45-degree field of view:
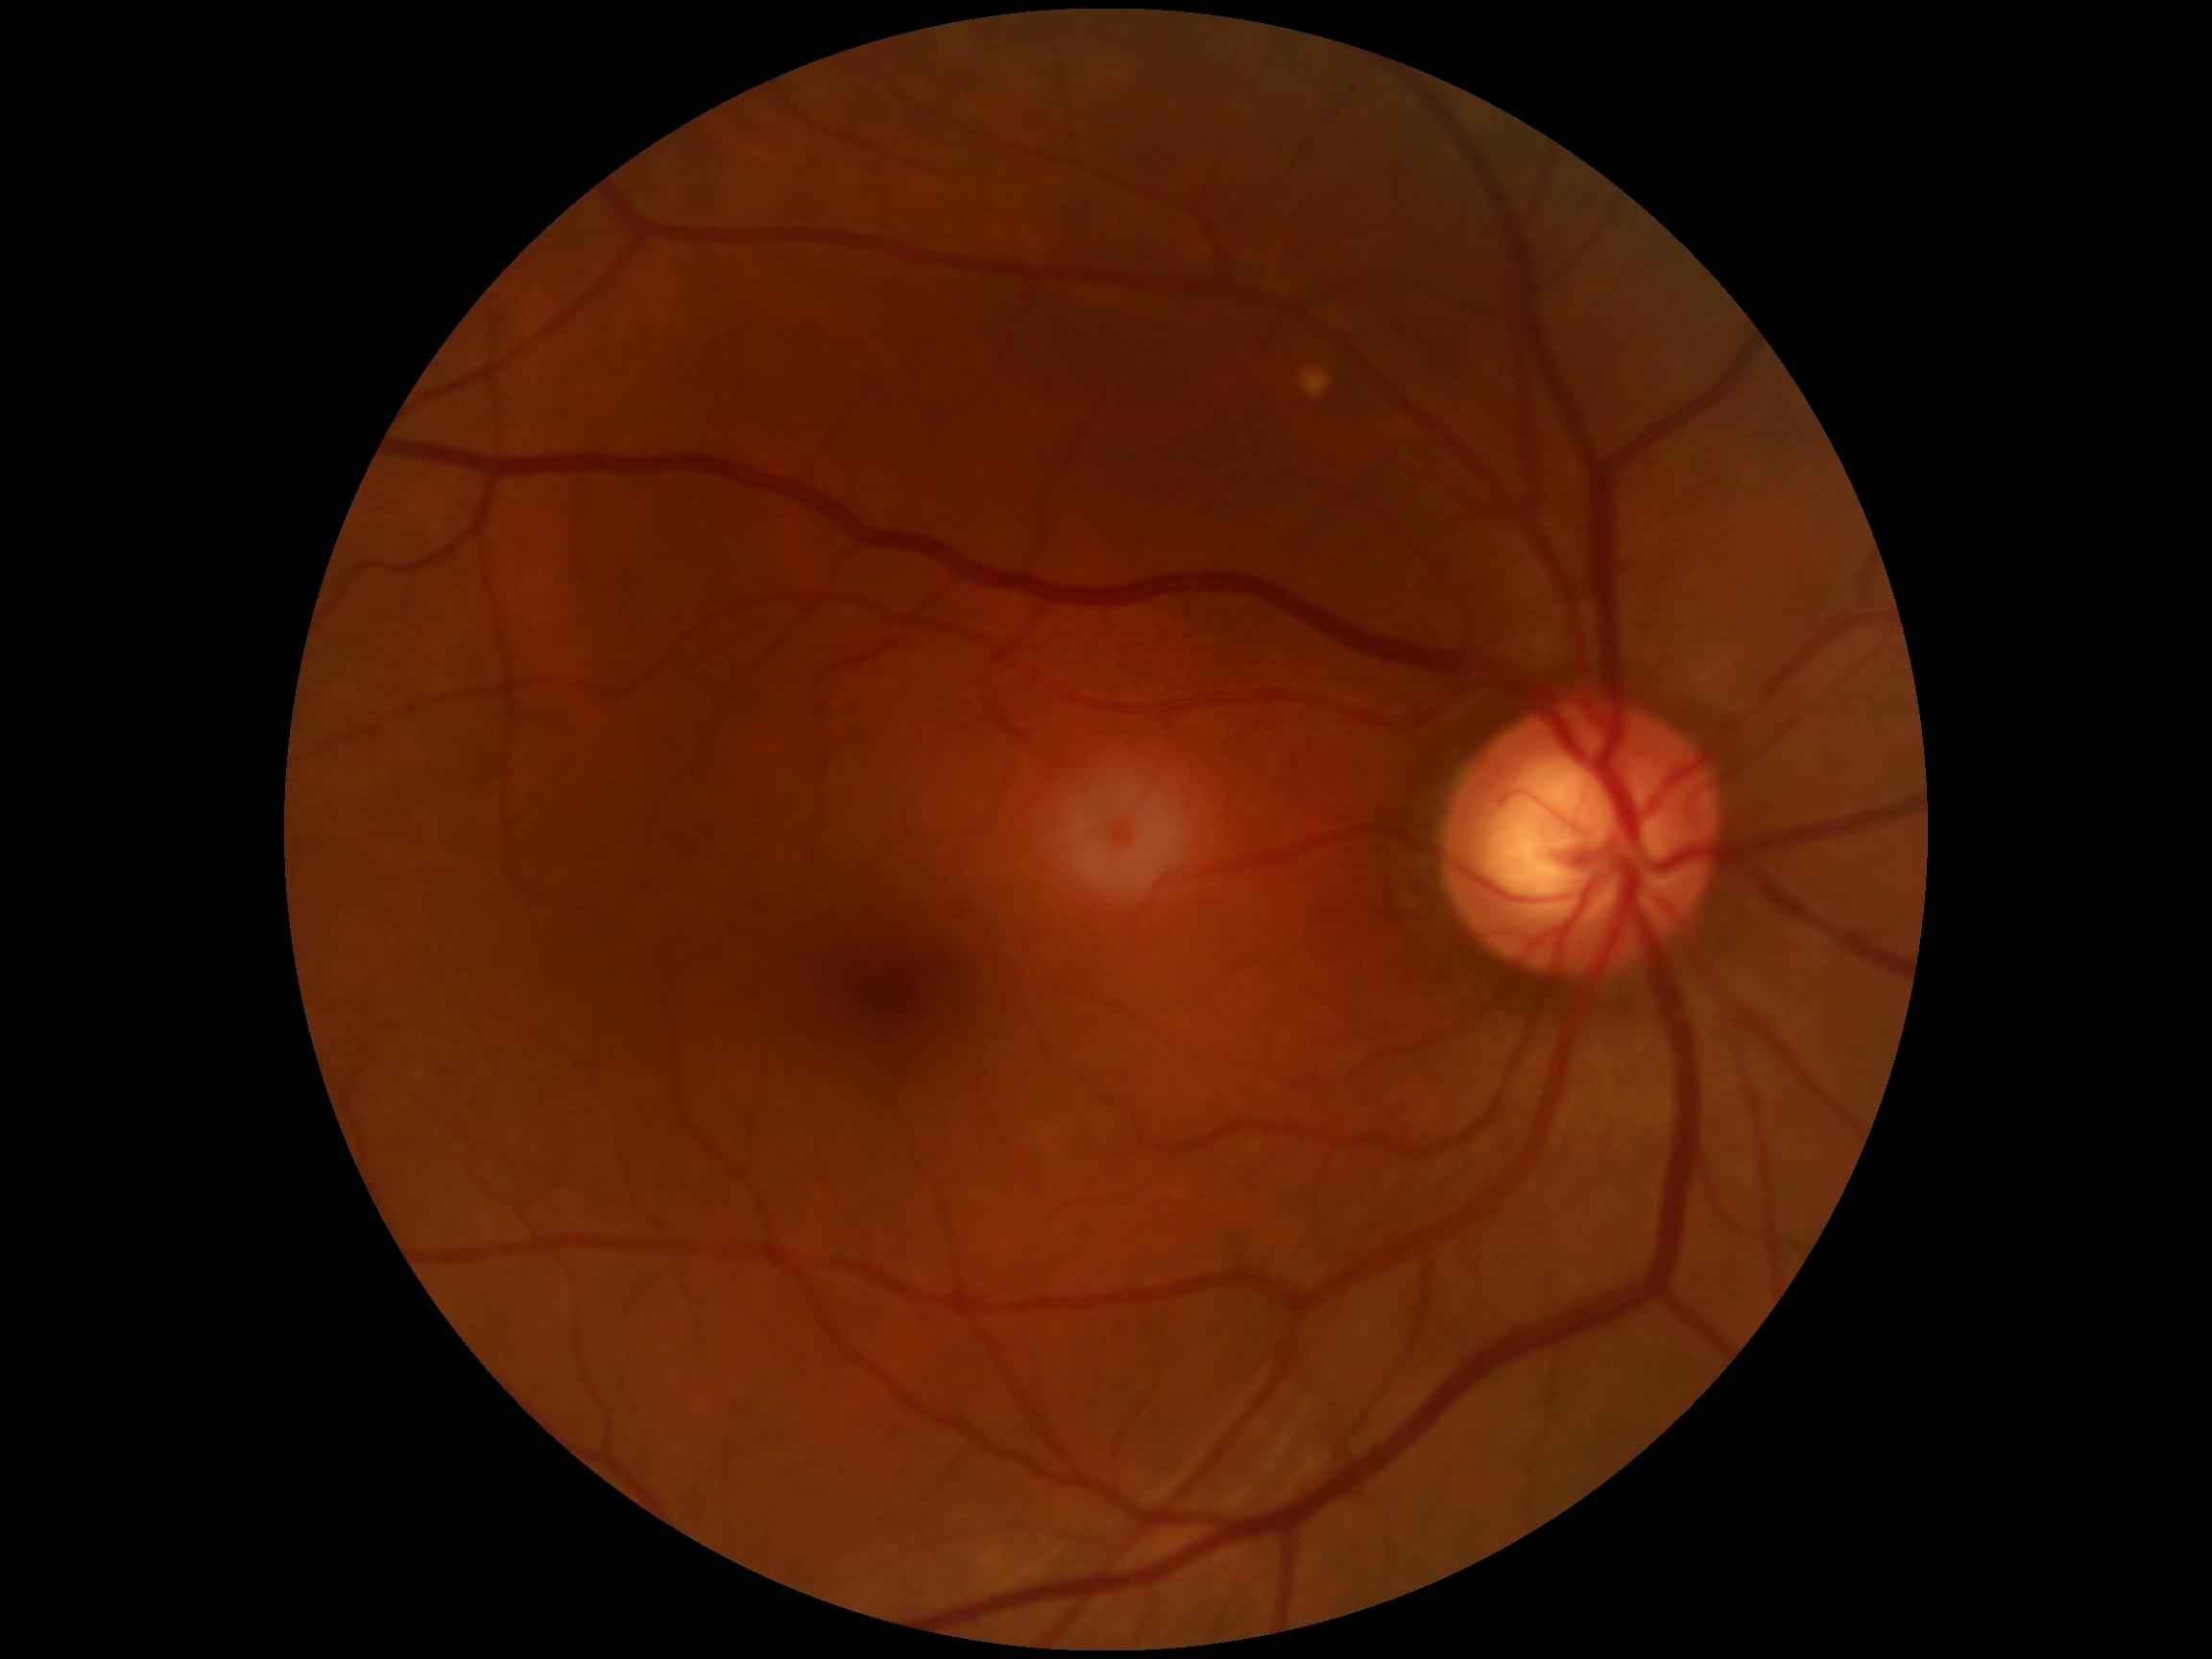

DR severity is grade 0 (no apparent retinopathy). No signs of diabetic retinopathy.